Modified Davis grading; color fundus photograph; FOV: 45 degrees: 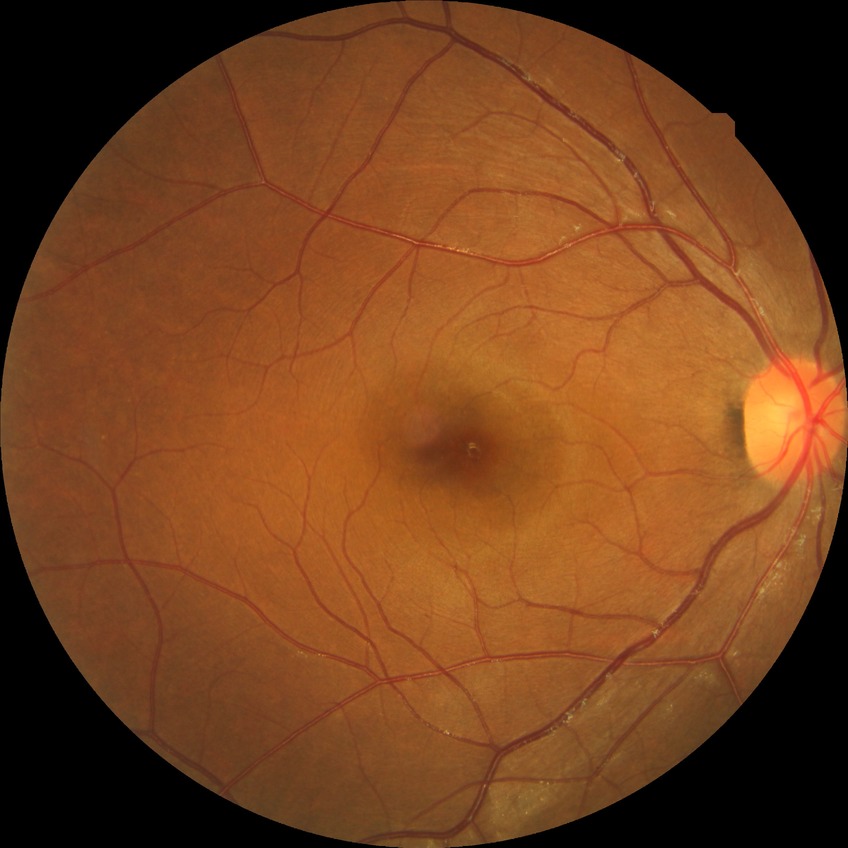 Davis stage is SDR.